45° FOV: 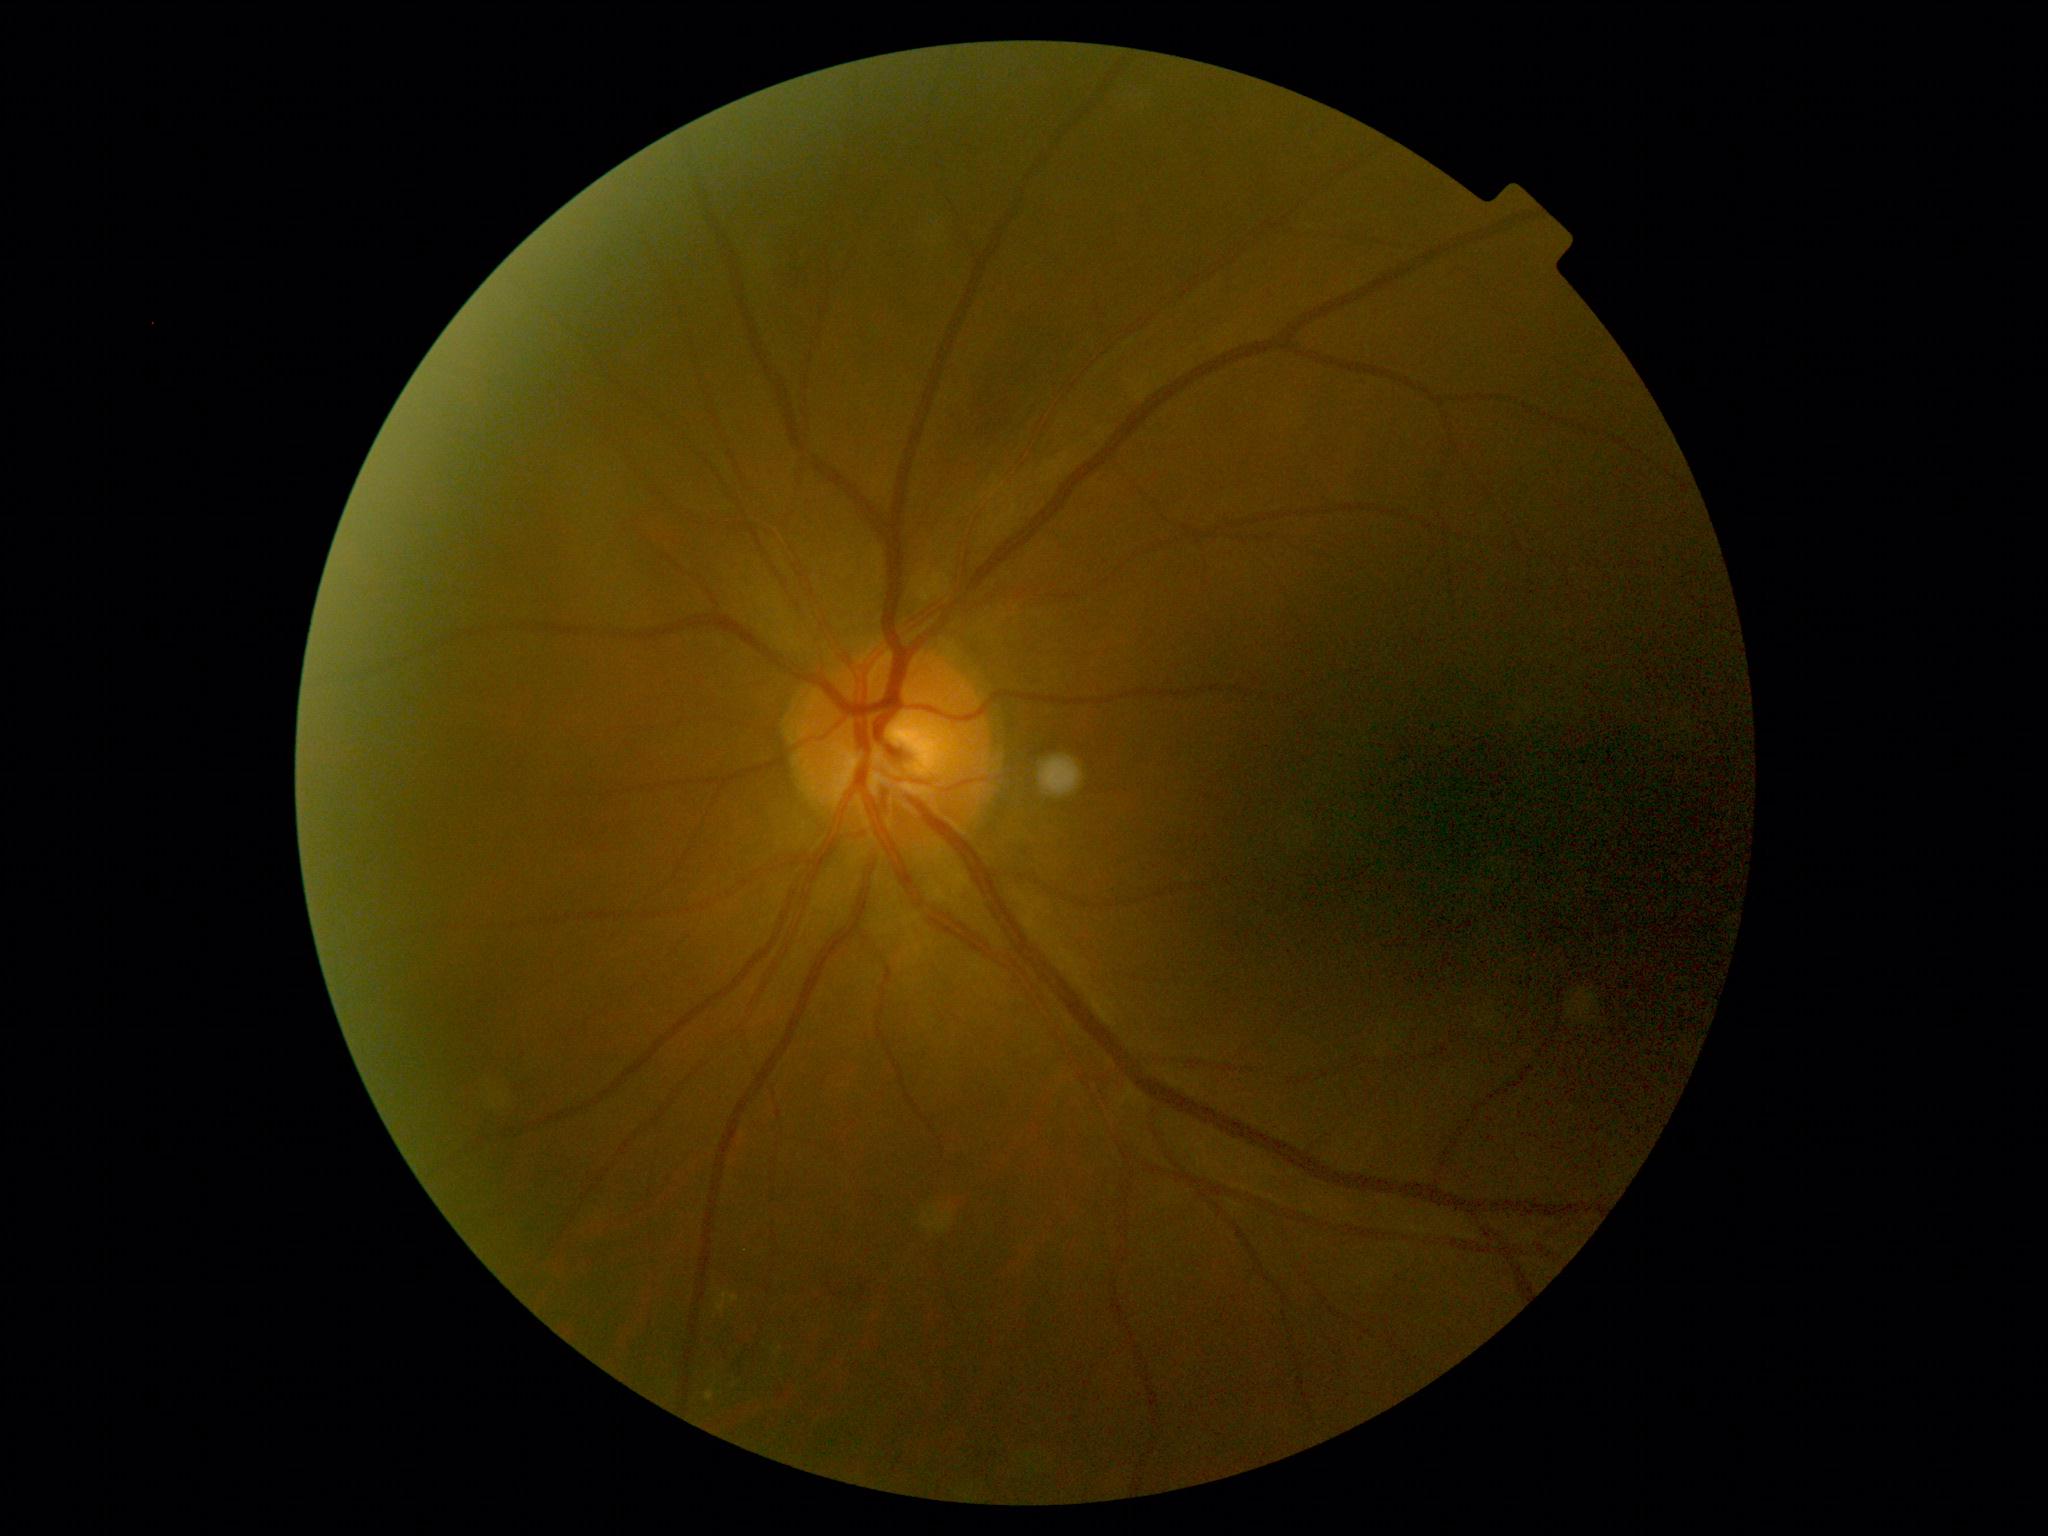
Annotations:
* DR — grade 2 (moderate NPDR) — more than just microaneurysms but less than severe NPDR